45-degree field of view · Davis DR grading:
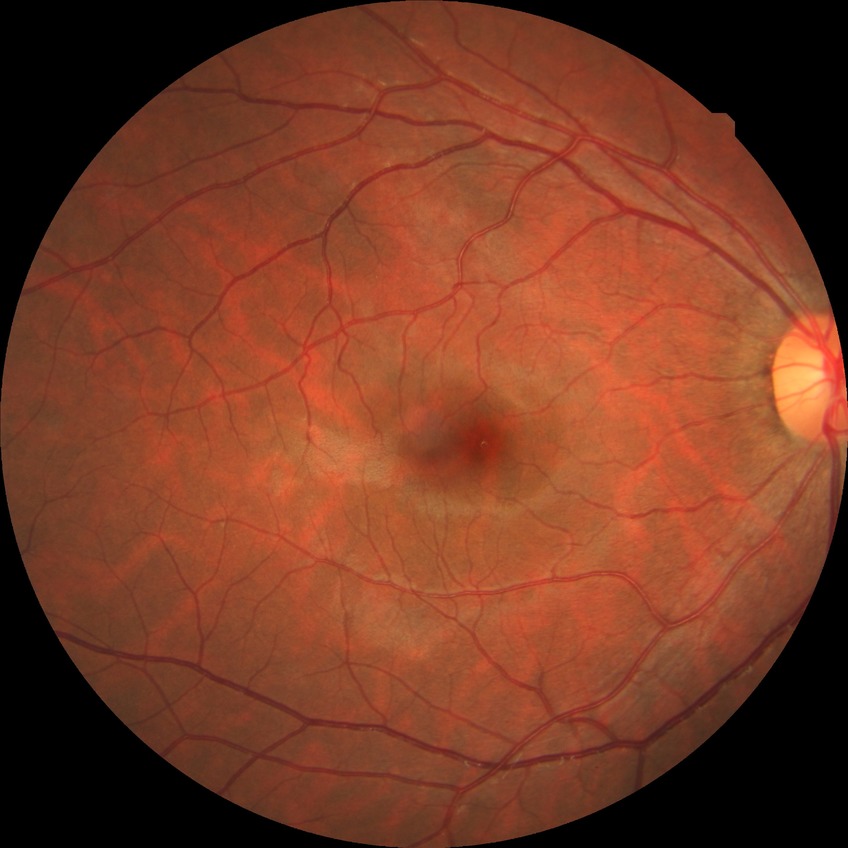

Davis DR grade: NDR.